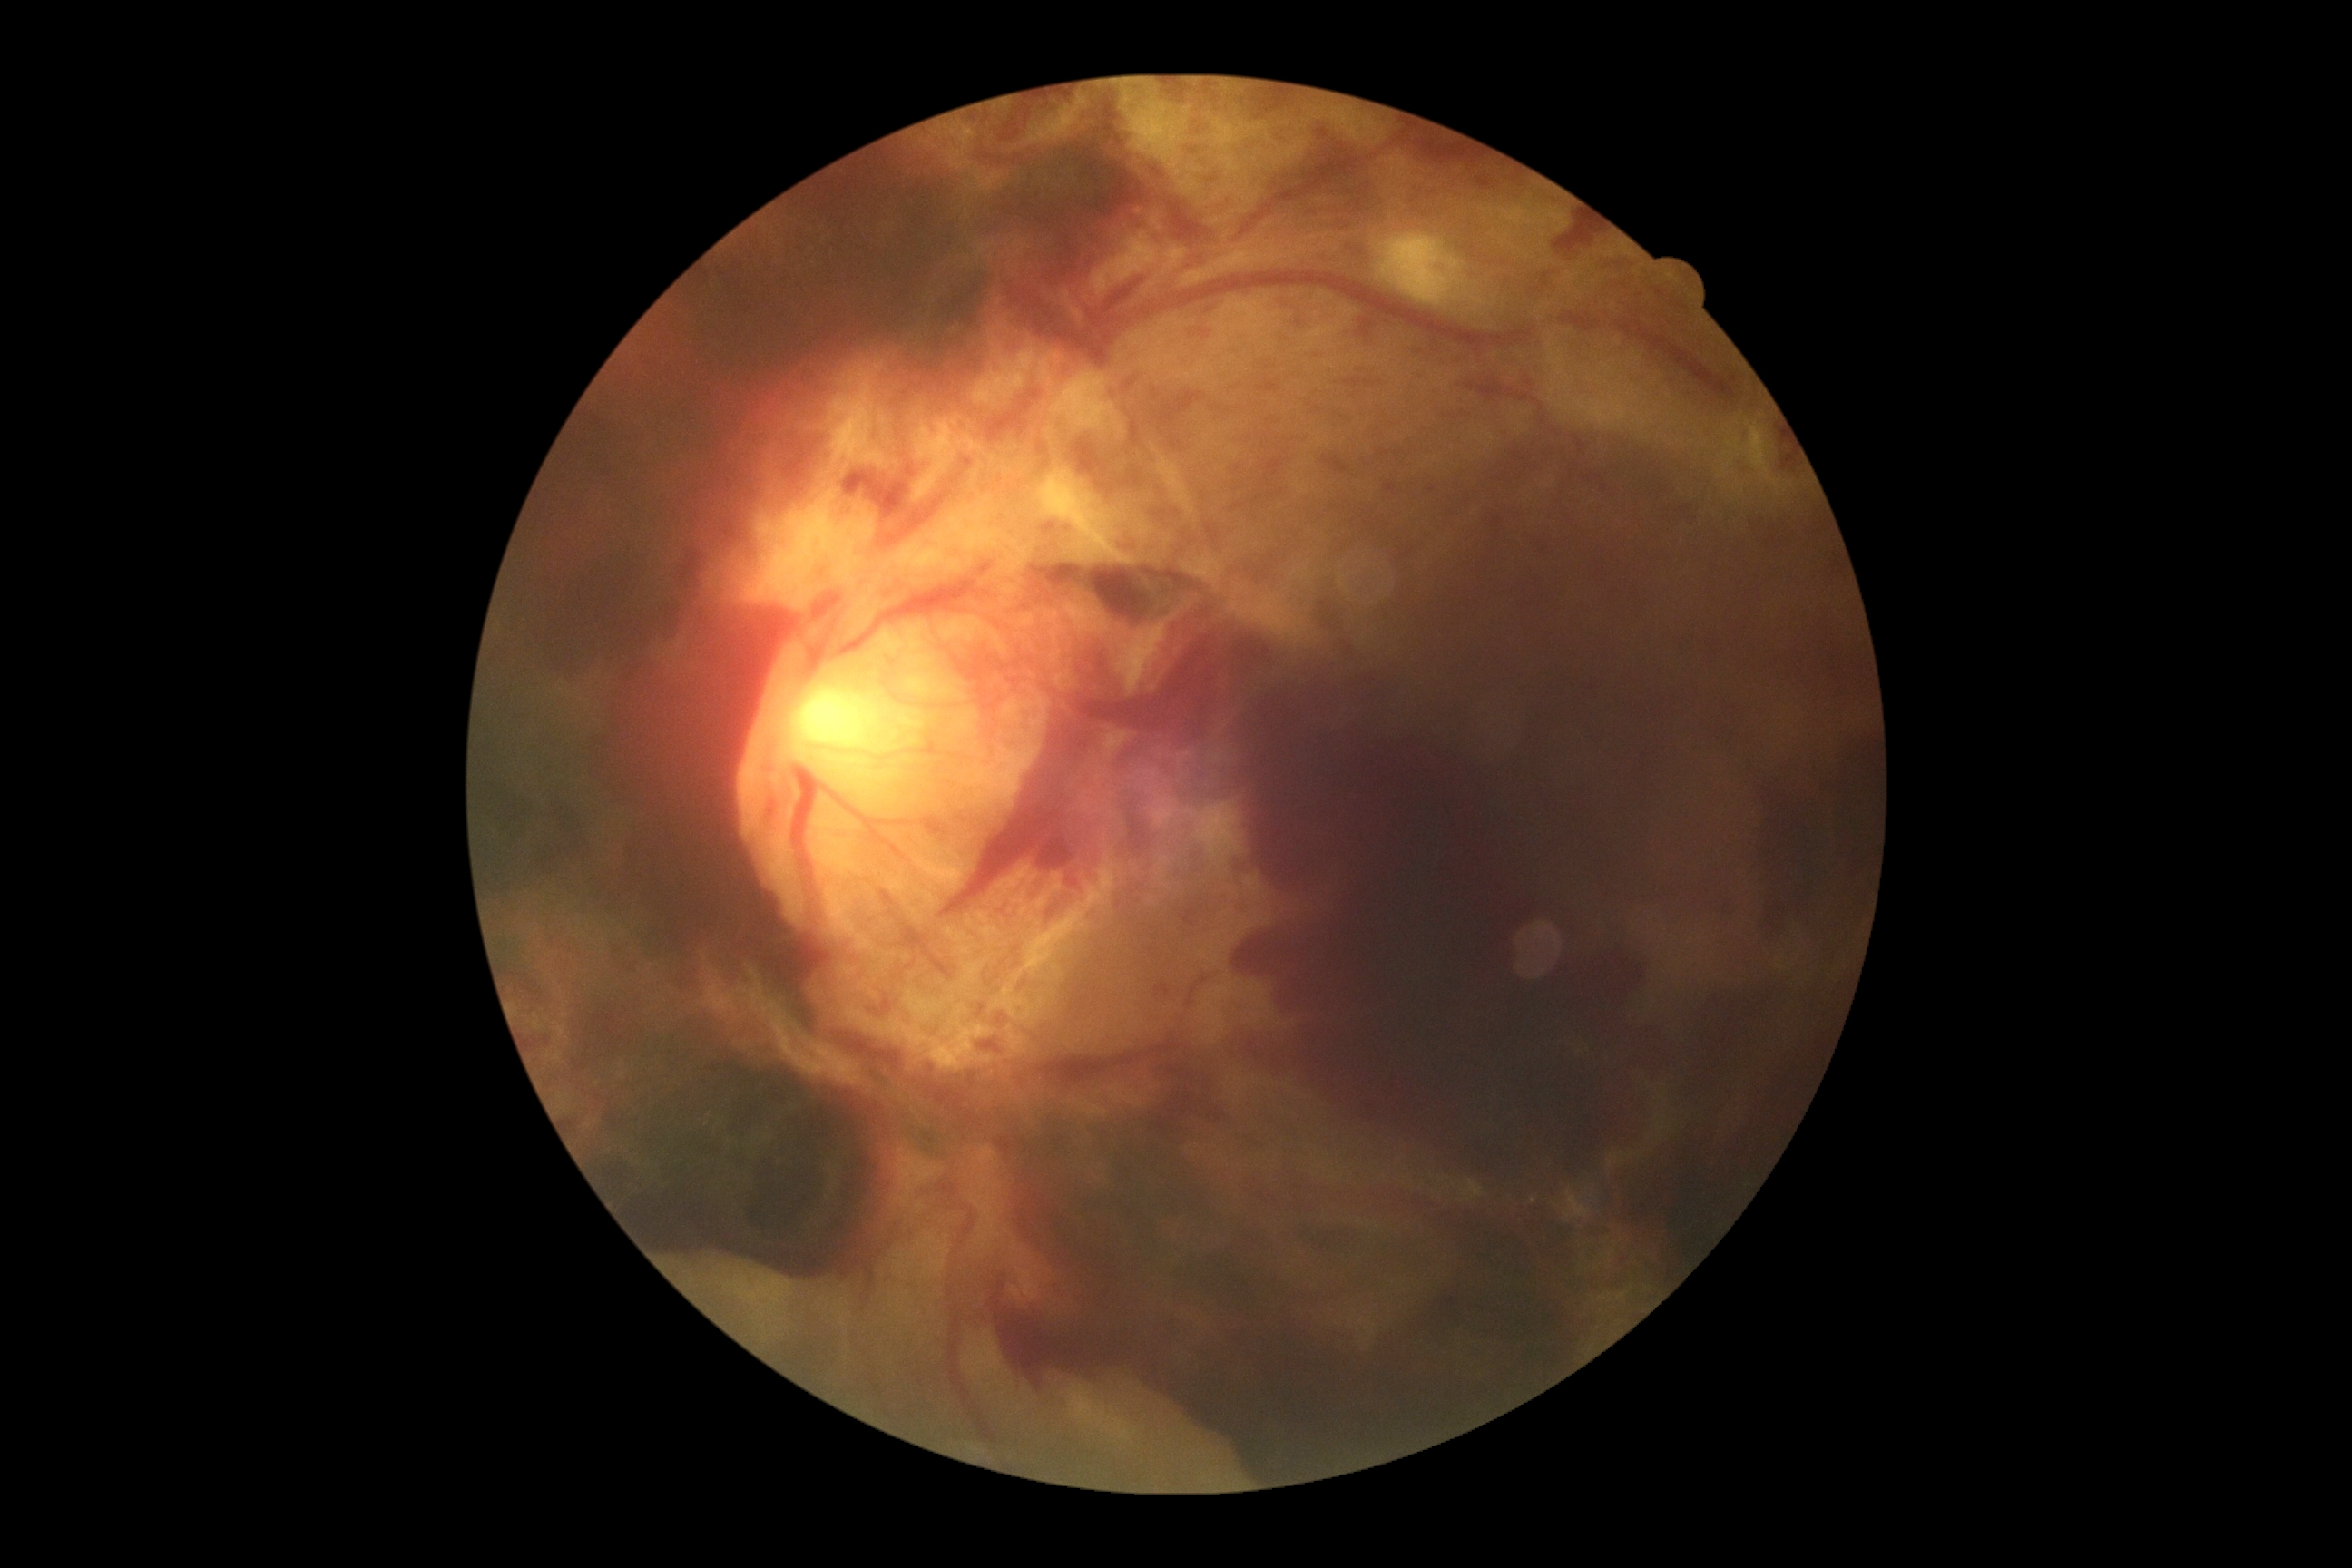 Diabetic retinopathy is PDR (grade 4).